Modified Davis grading; NIDEK AFC-230: 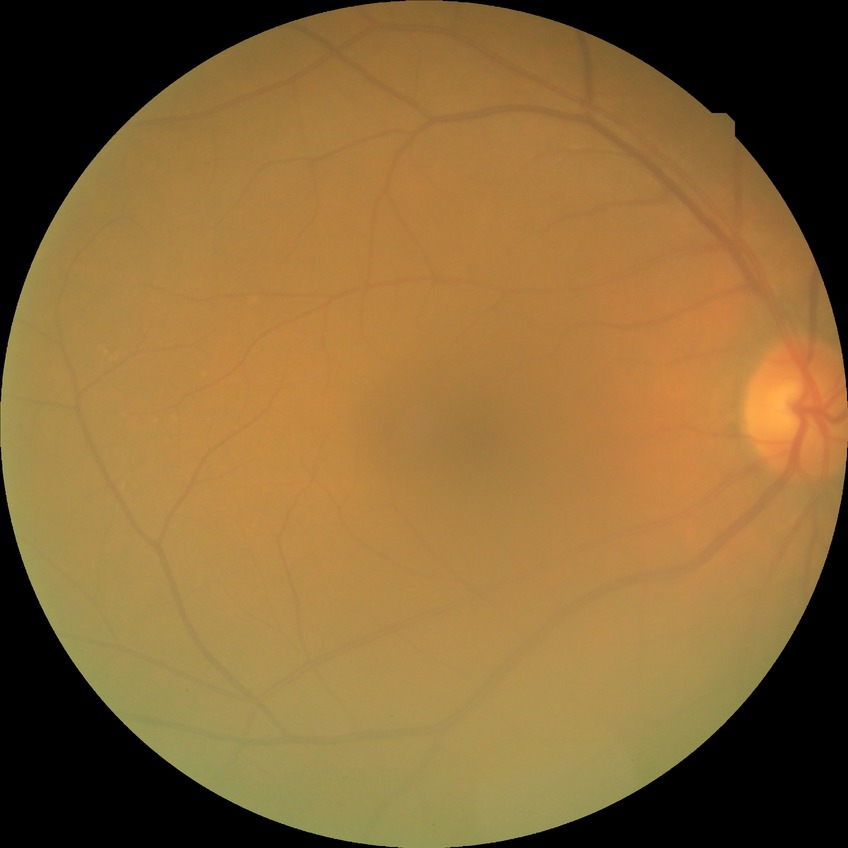

Annotations:
- retinopathy grade: no diabetic retinopathy